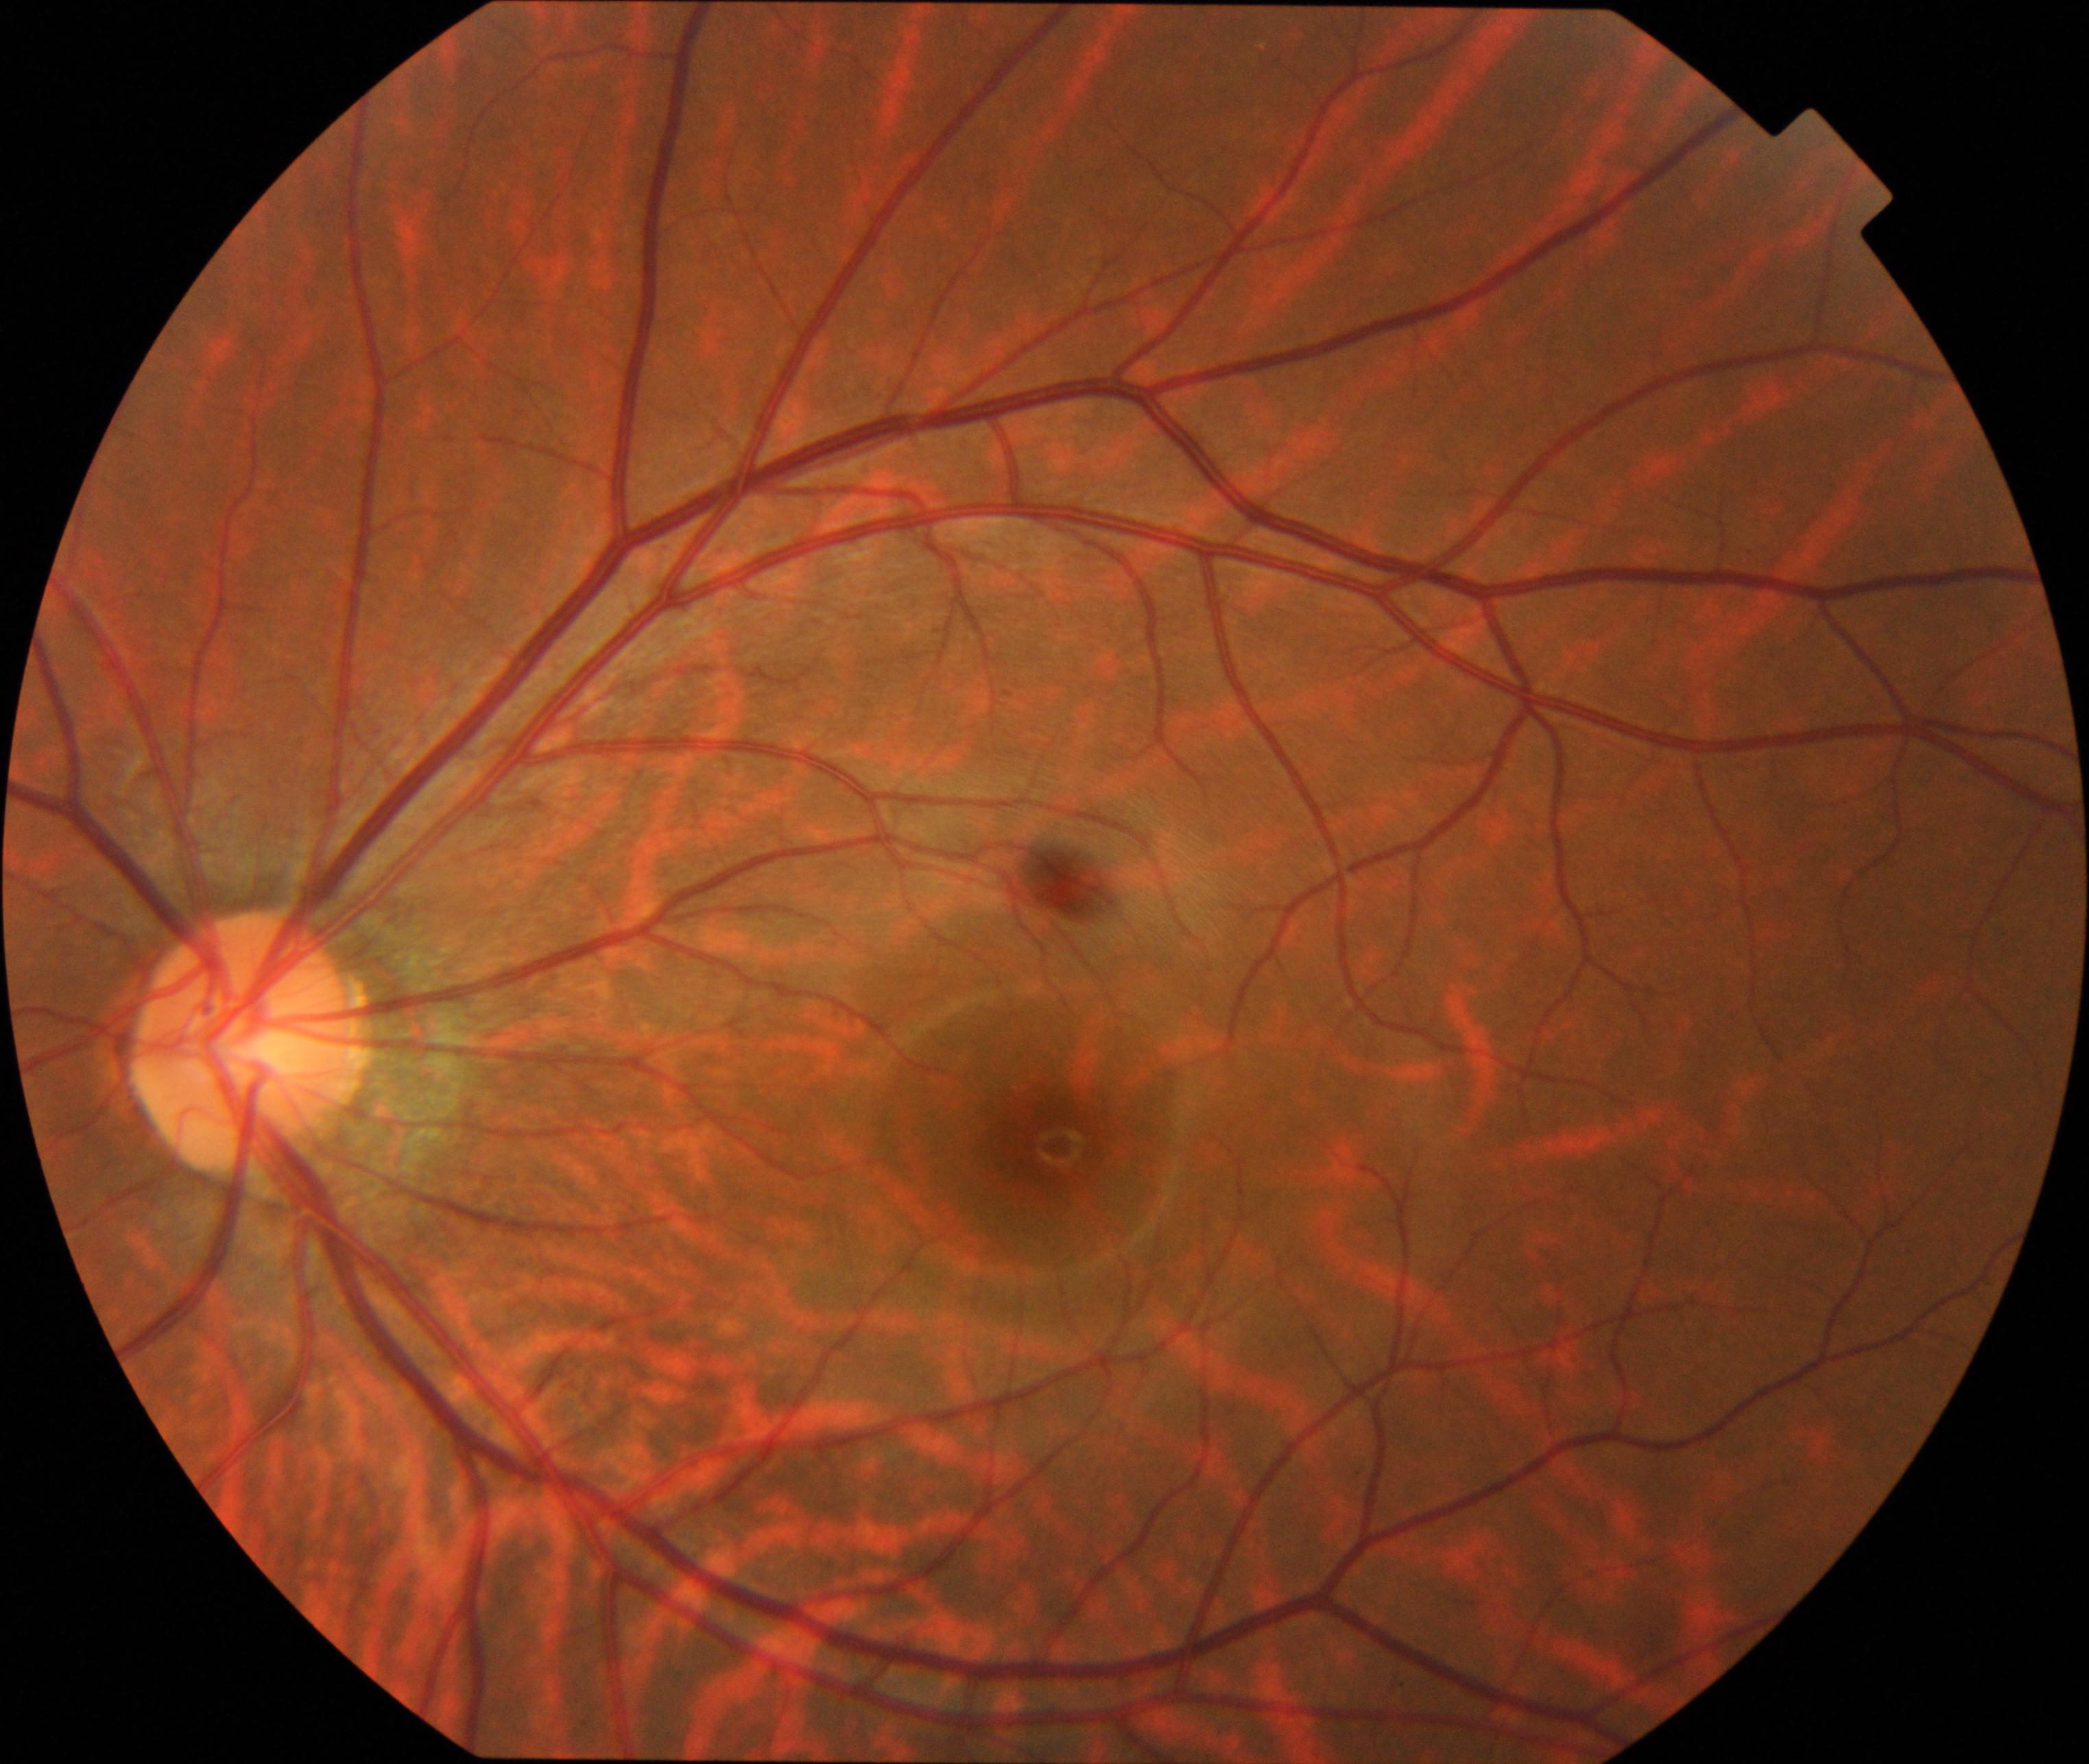
Demonstrates tessellated fundus.